45° field of view · 2048x1536 · retinal fundus photograph
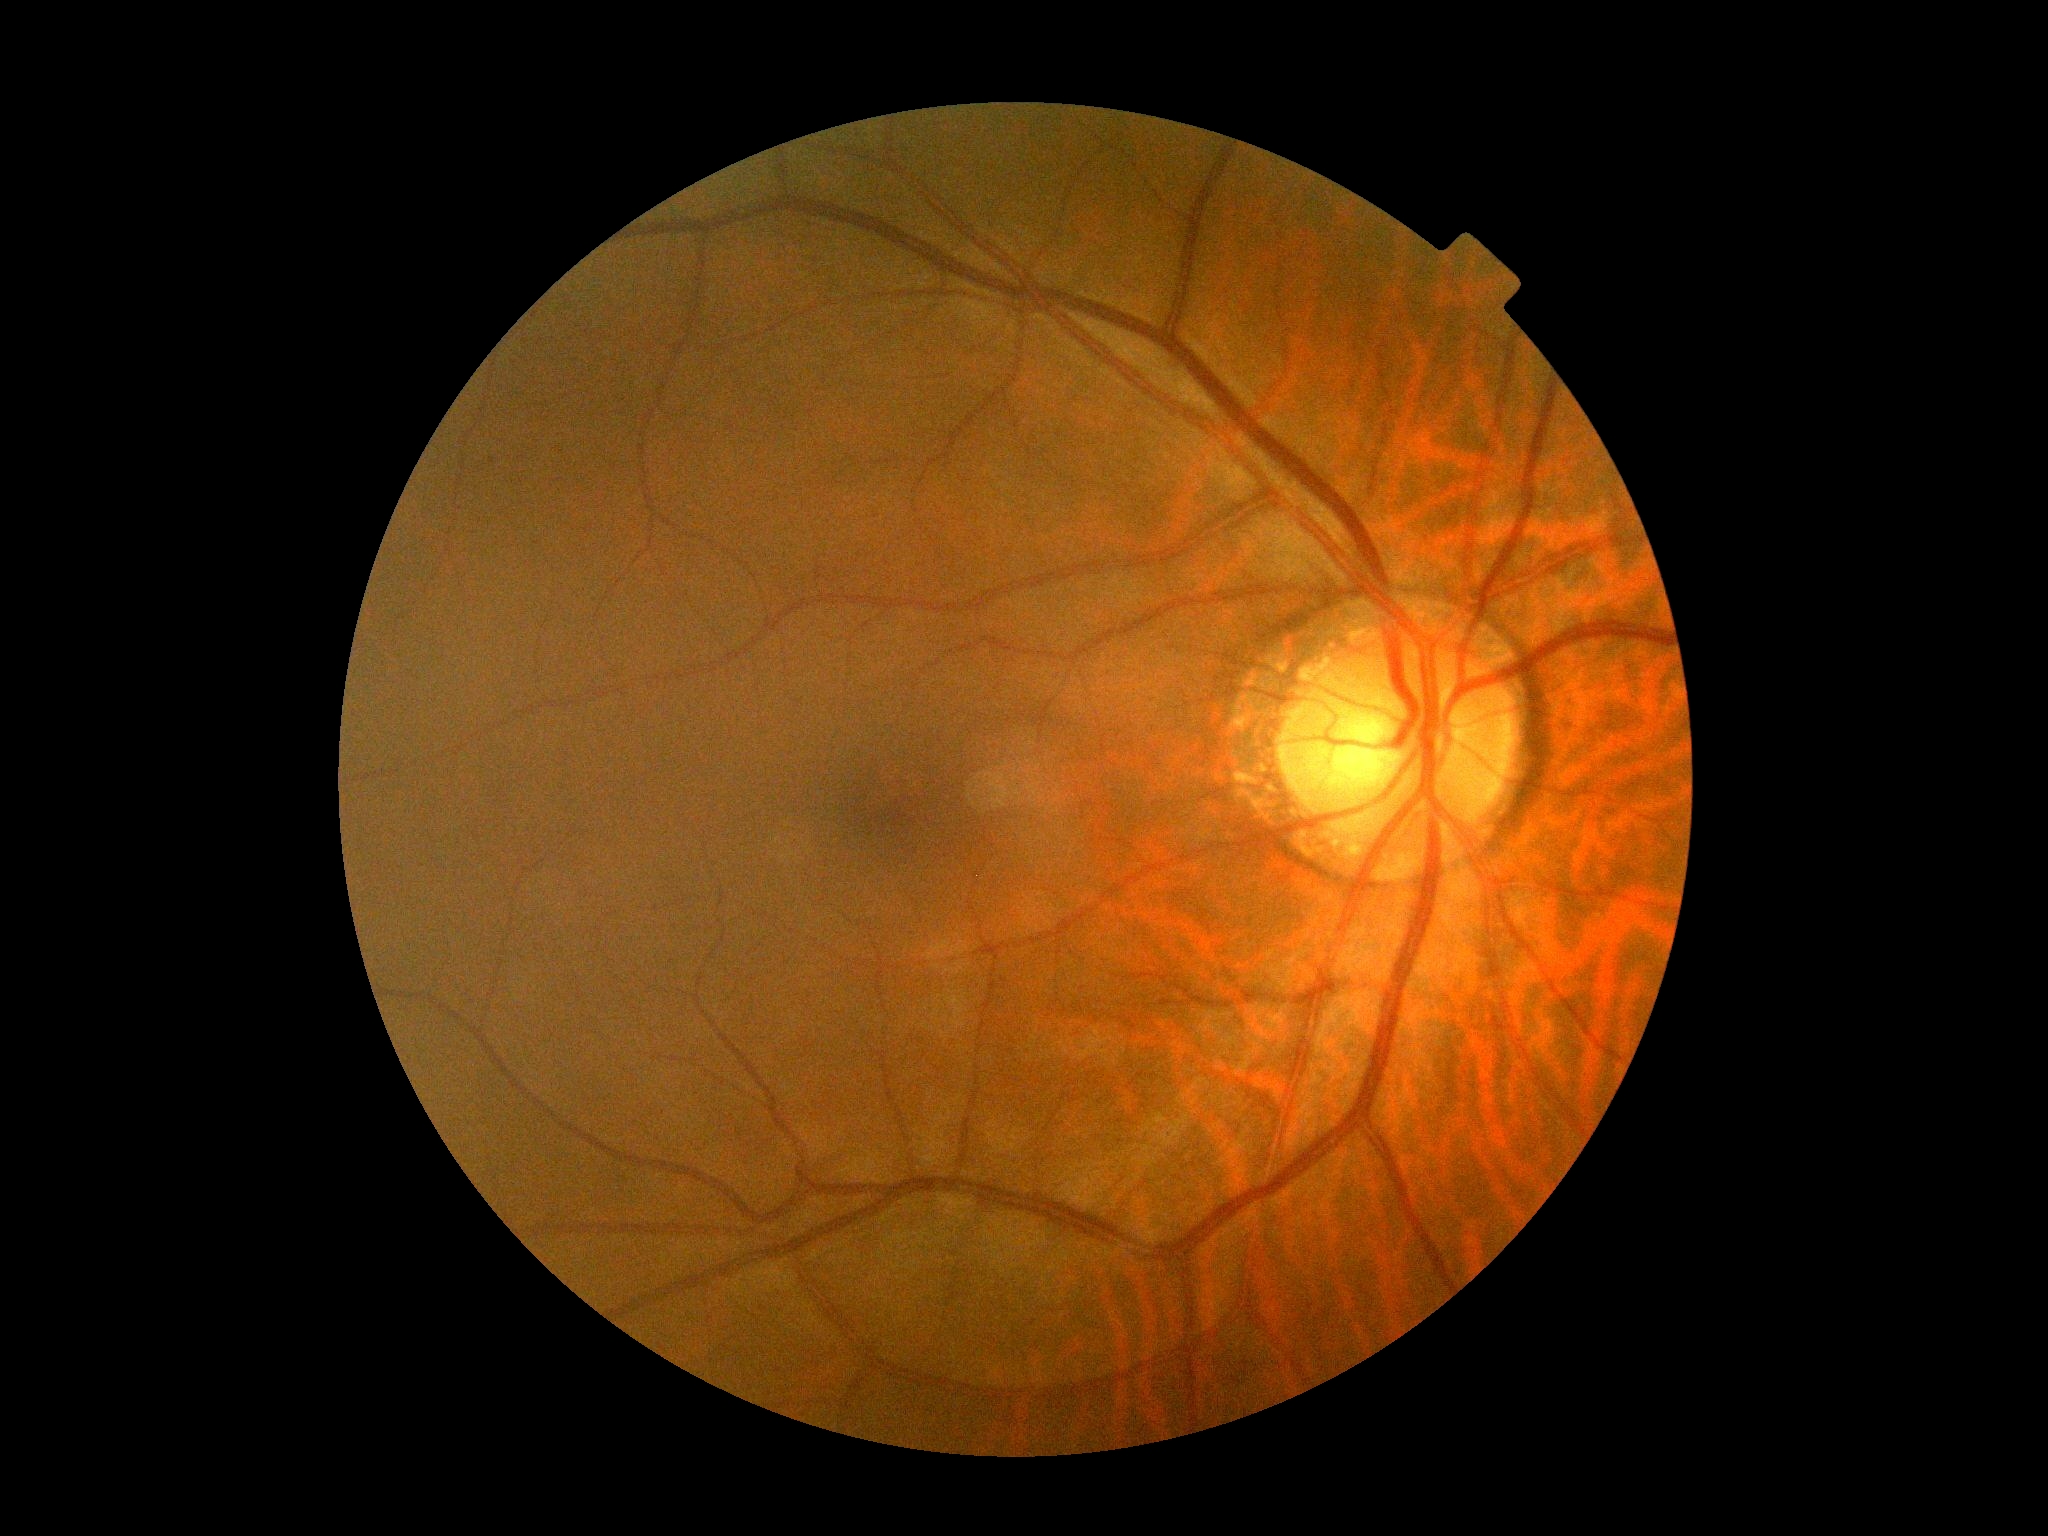

Diabetic retinopathy (DR): 0/4 — no visible signs of diabetic retinopathy.